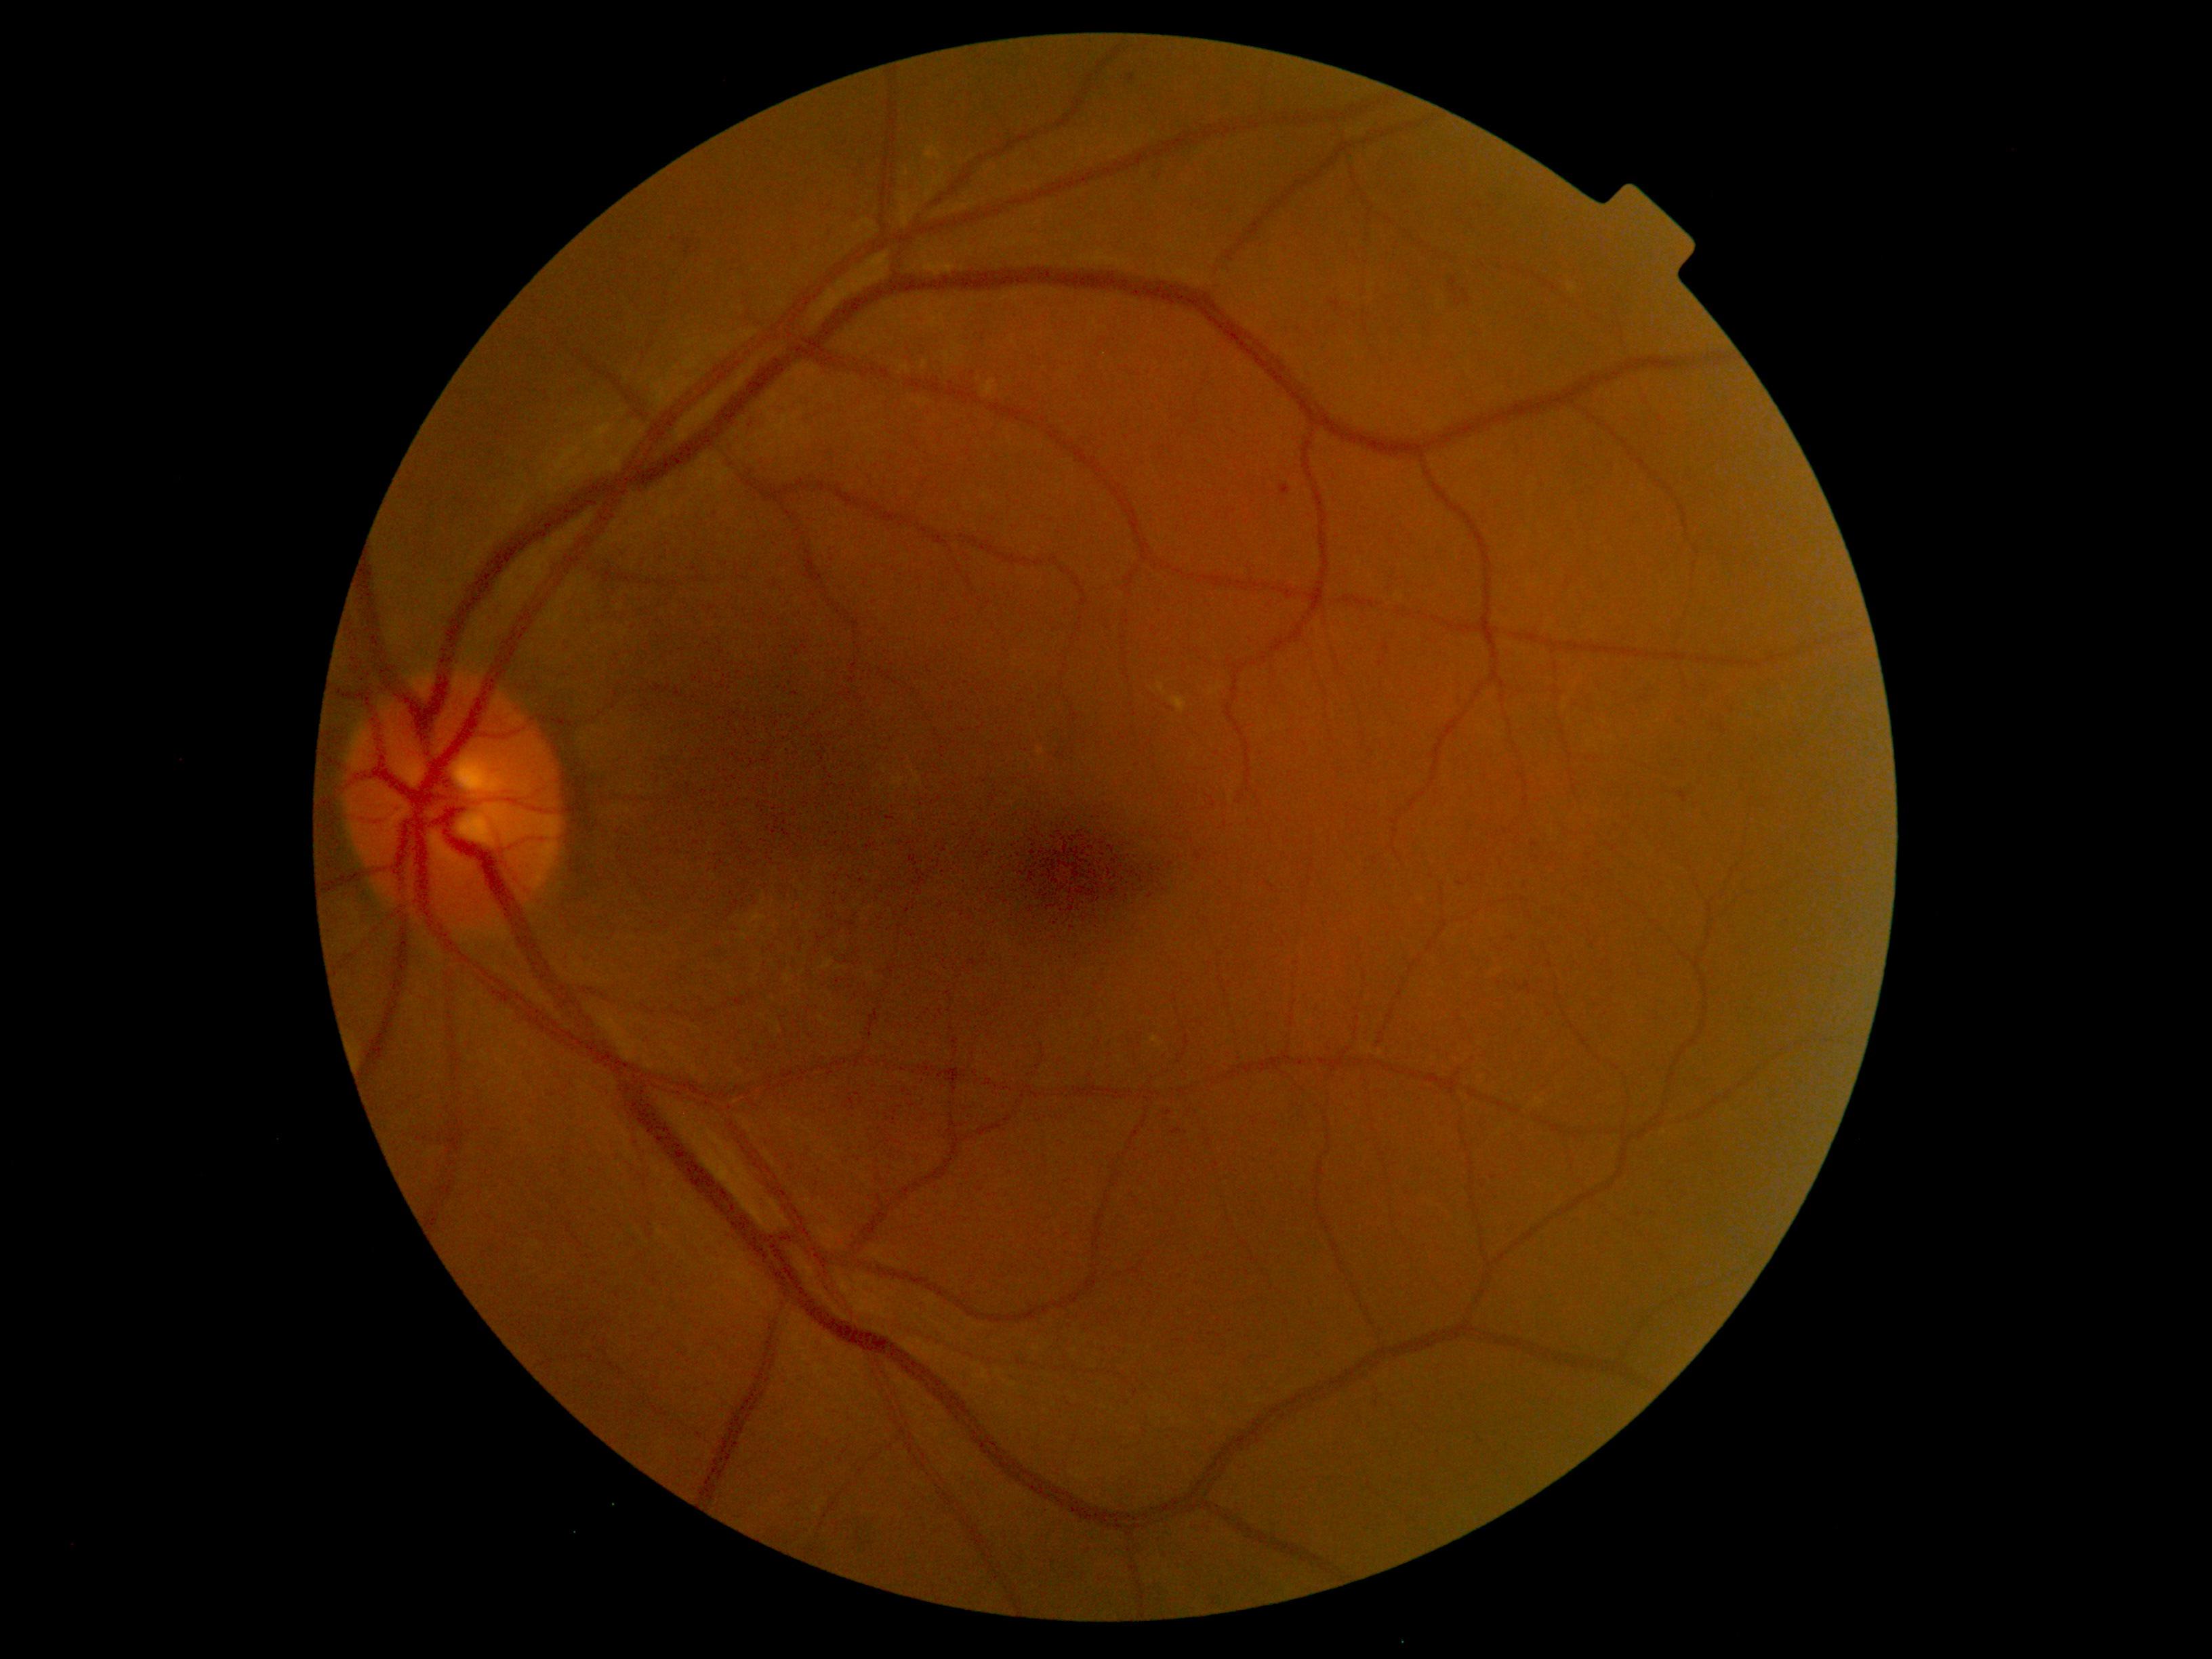
DR class=non-proliferative diabetic retinopathy; retinopathy=grade 2 (moderate NPDR).